100° field of view (Phoenix ICON) · wide-field fundus photograph from neonatal ROP screening — 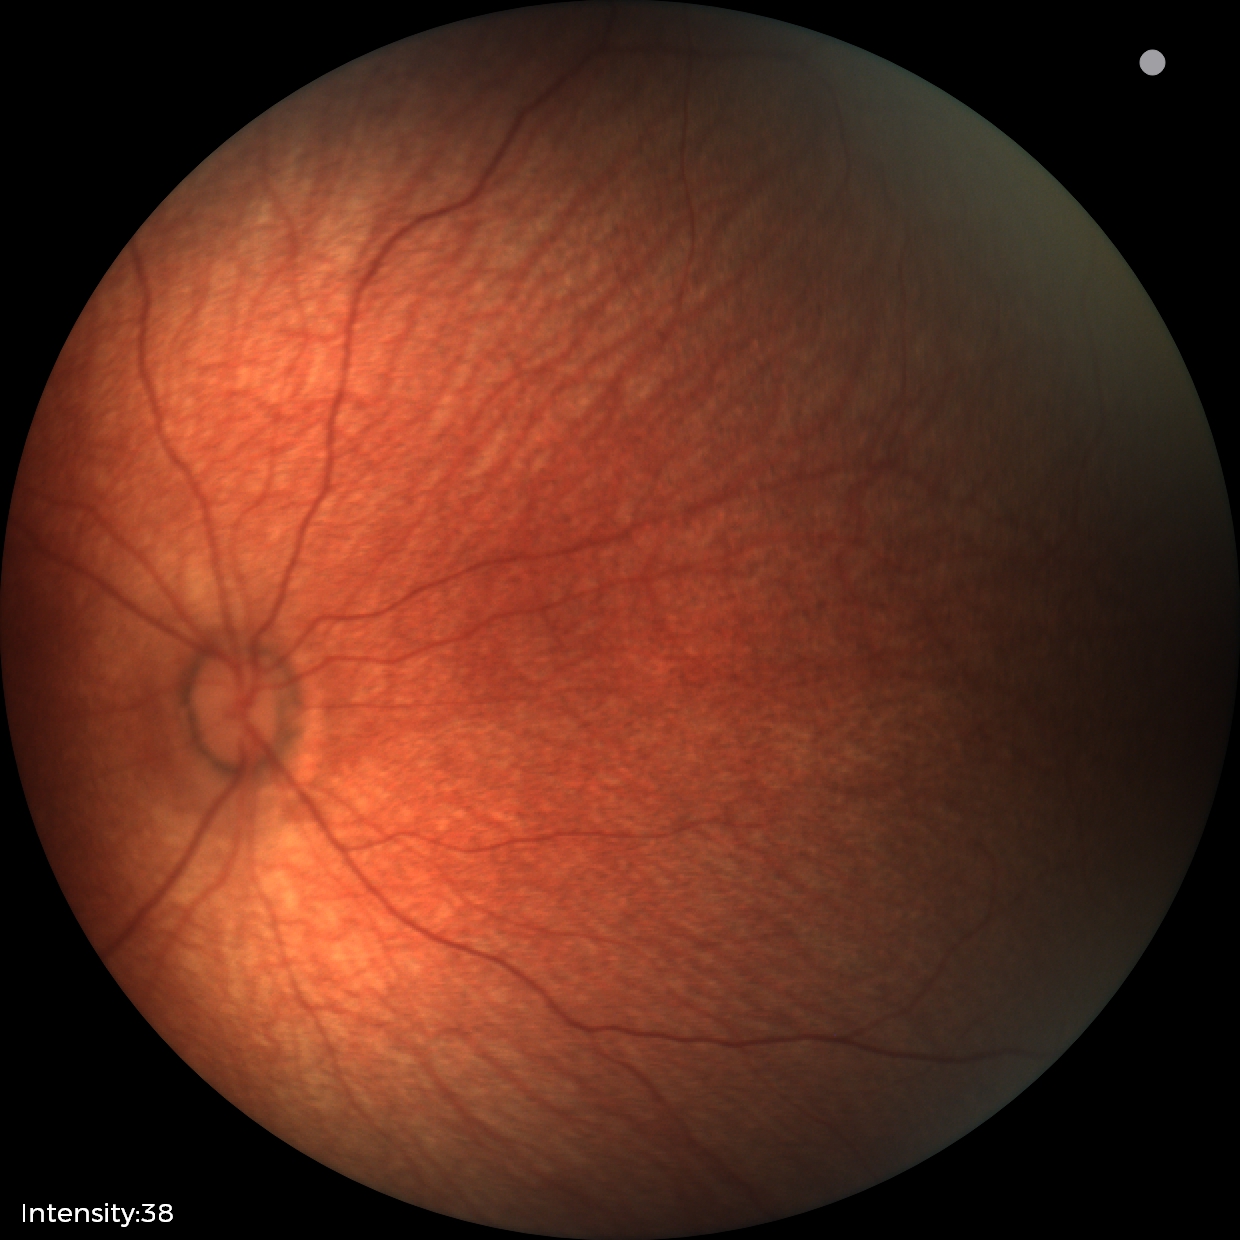 Normal screening examination.